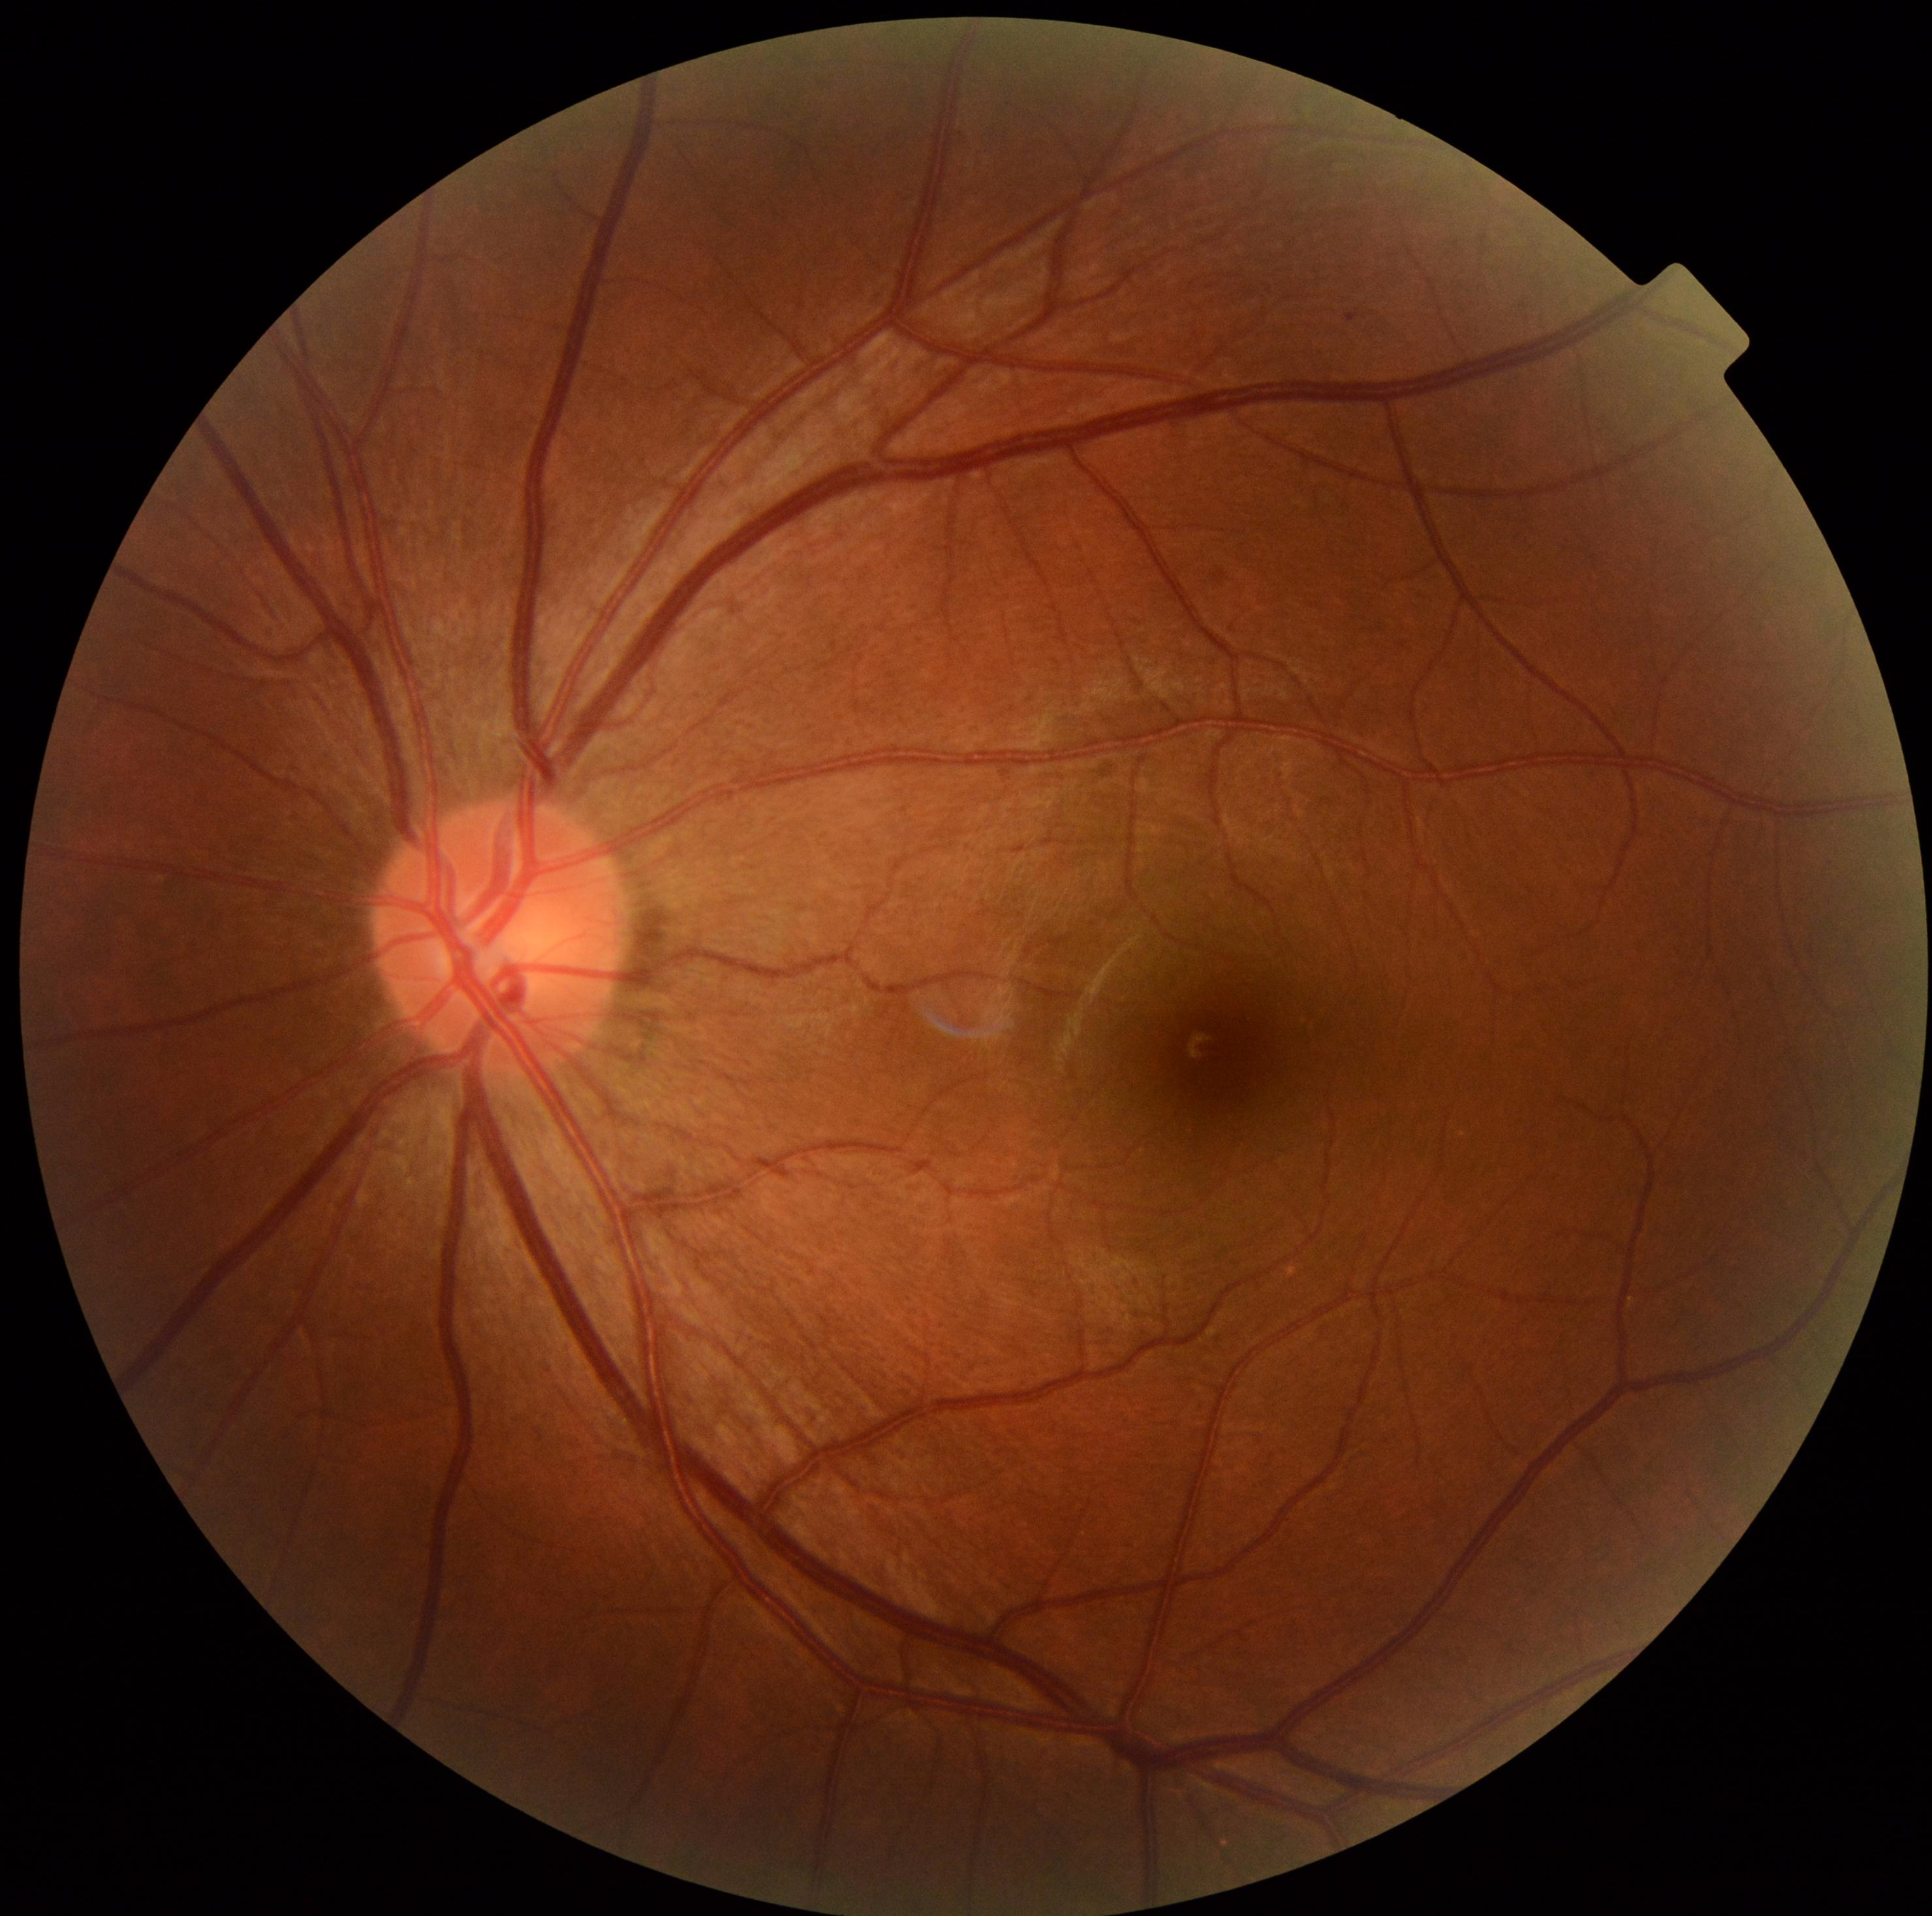 Annotations:
– diabetic retinopathy (DR): 1/4 — presence of microaneurysms only